Retinal fundus photograph:
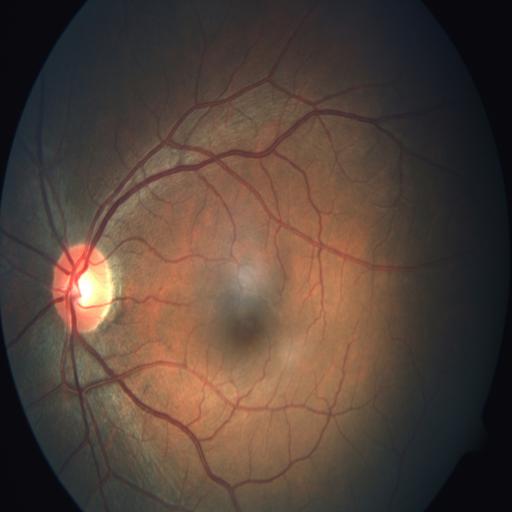 Findings: none. Normal fundus.